2352 by 1568 pixels:
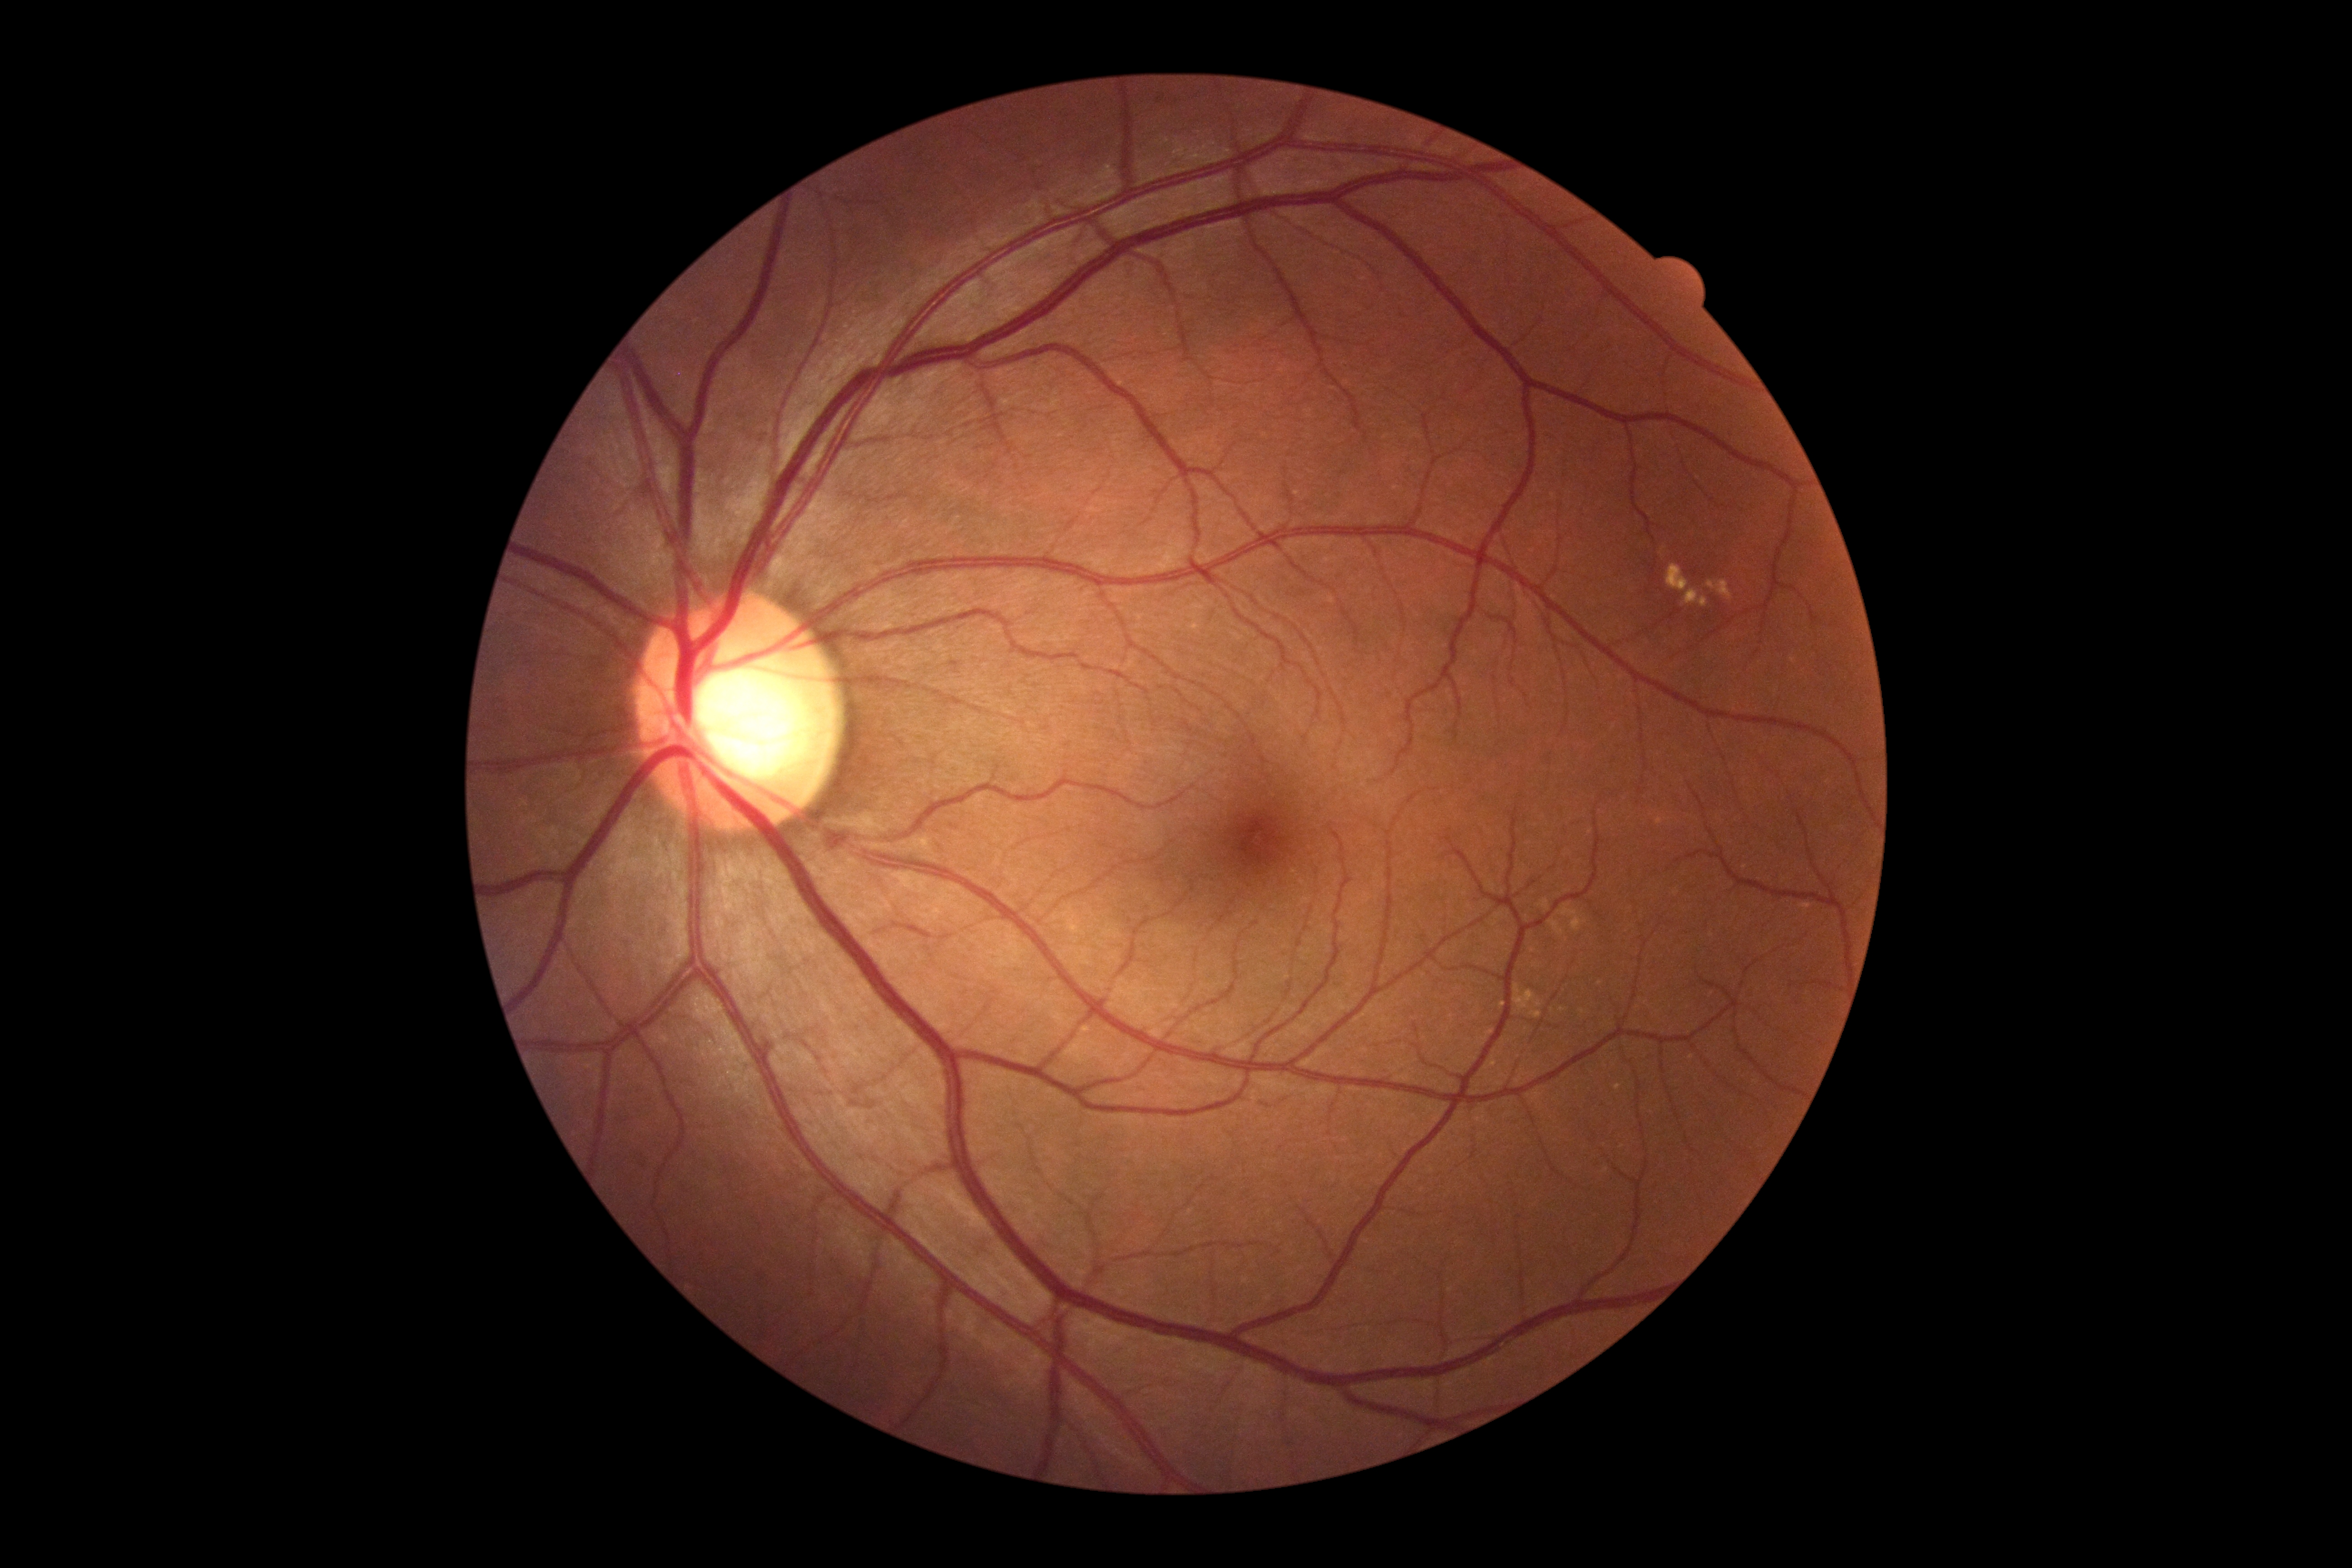

{
  "dr_grade": "0"
}